512x512px — 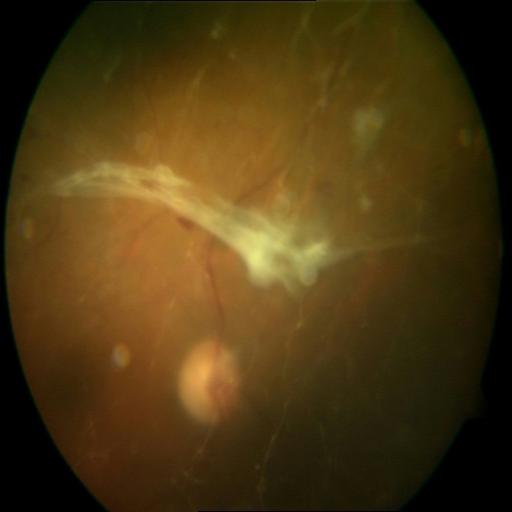
Pathology: retinal traction (RT).